NIDEK AFC-230 fundus camera — 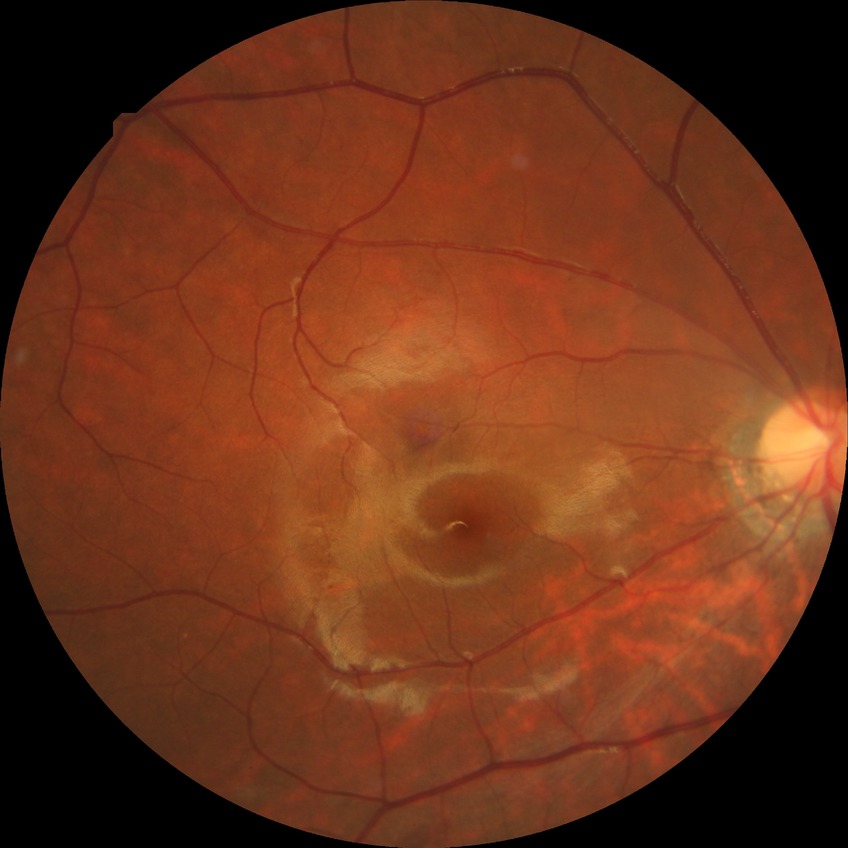 Diabetic retinopathy (DR): no diabetic retinopathy (NDR).